Retinal fundus photograph; acquired with a NIDEK AFC-230; modified Davis grading; 45-degree field of view; nonmydriatic — 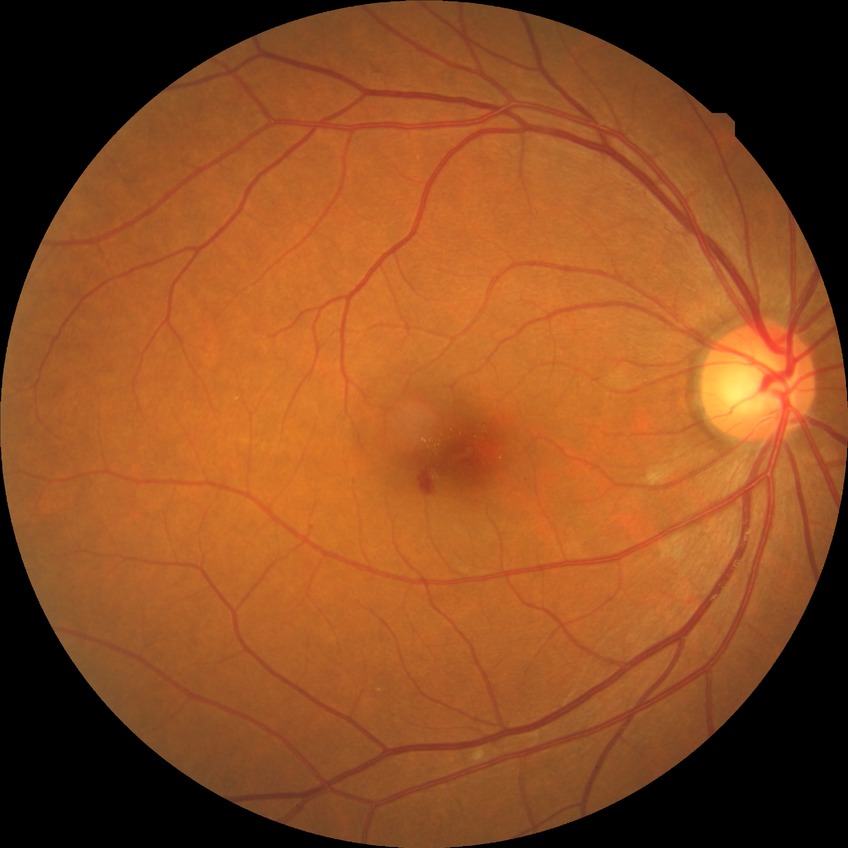

diabetic retinopathy grade: simple diabetic retinopathy.